848x848.
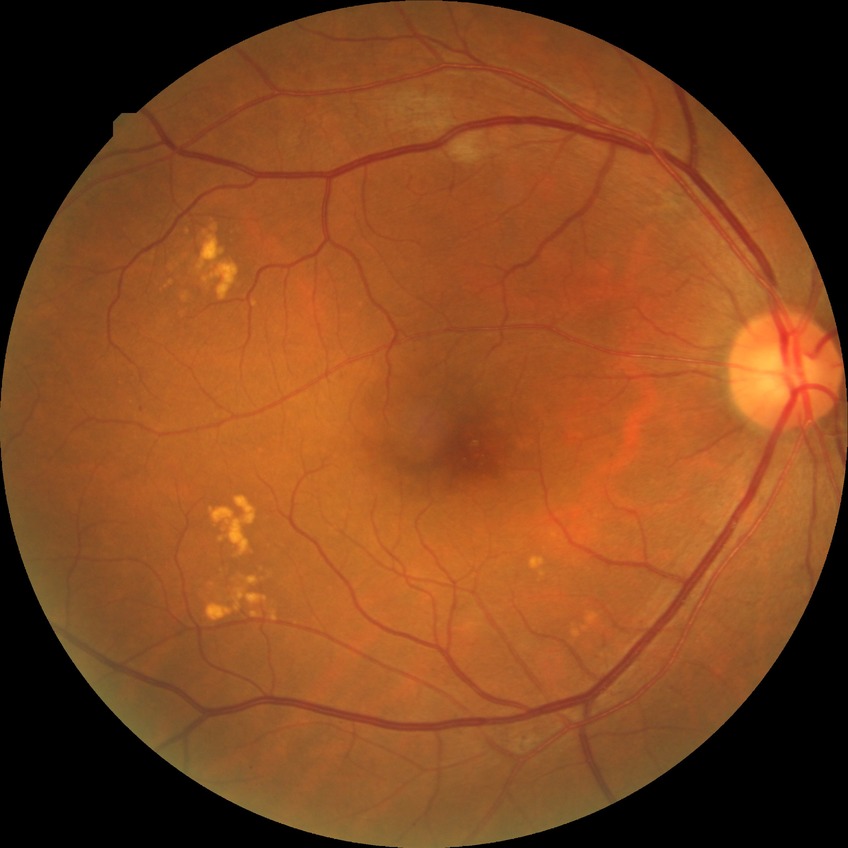

Findings:
• DR grade: SDR